848x848. NIDEK AFC-230 fundus camera. Nonmydriatic fundus photograph — 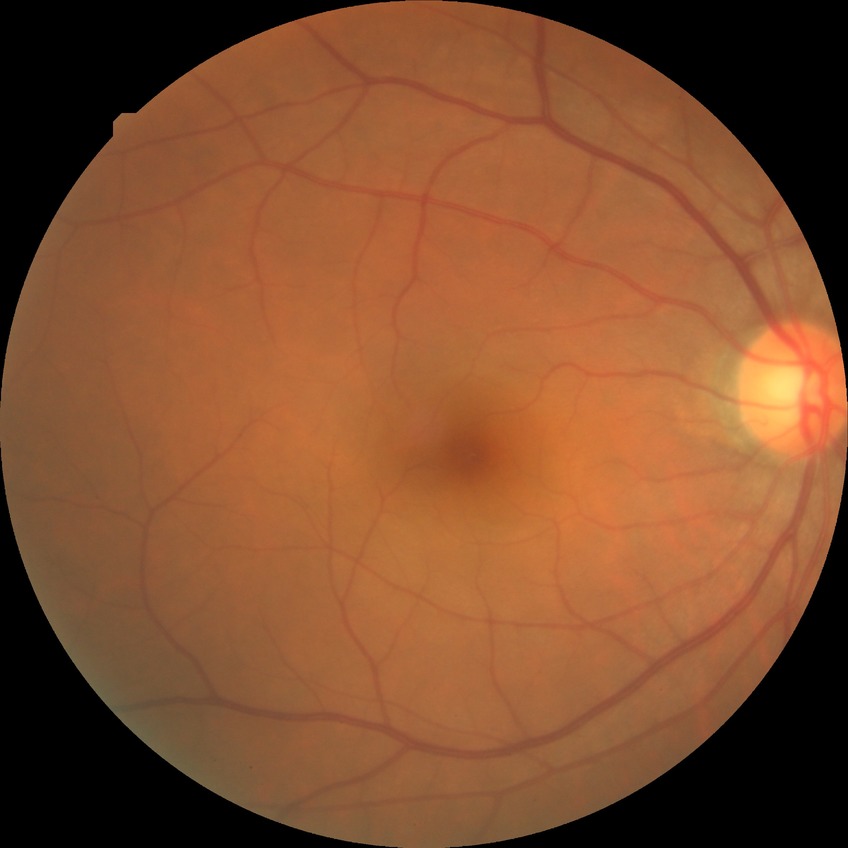
No signs of diabetic retinopathy.
DR grade: NDR.